Remidio smartphone fundus camera
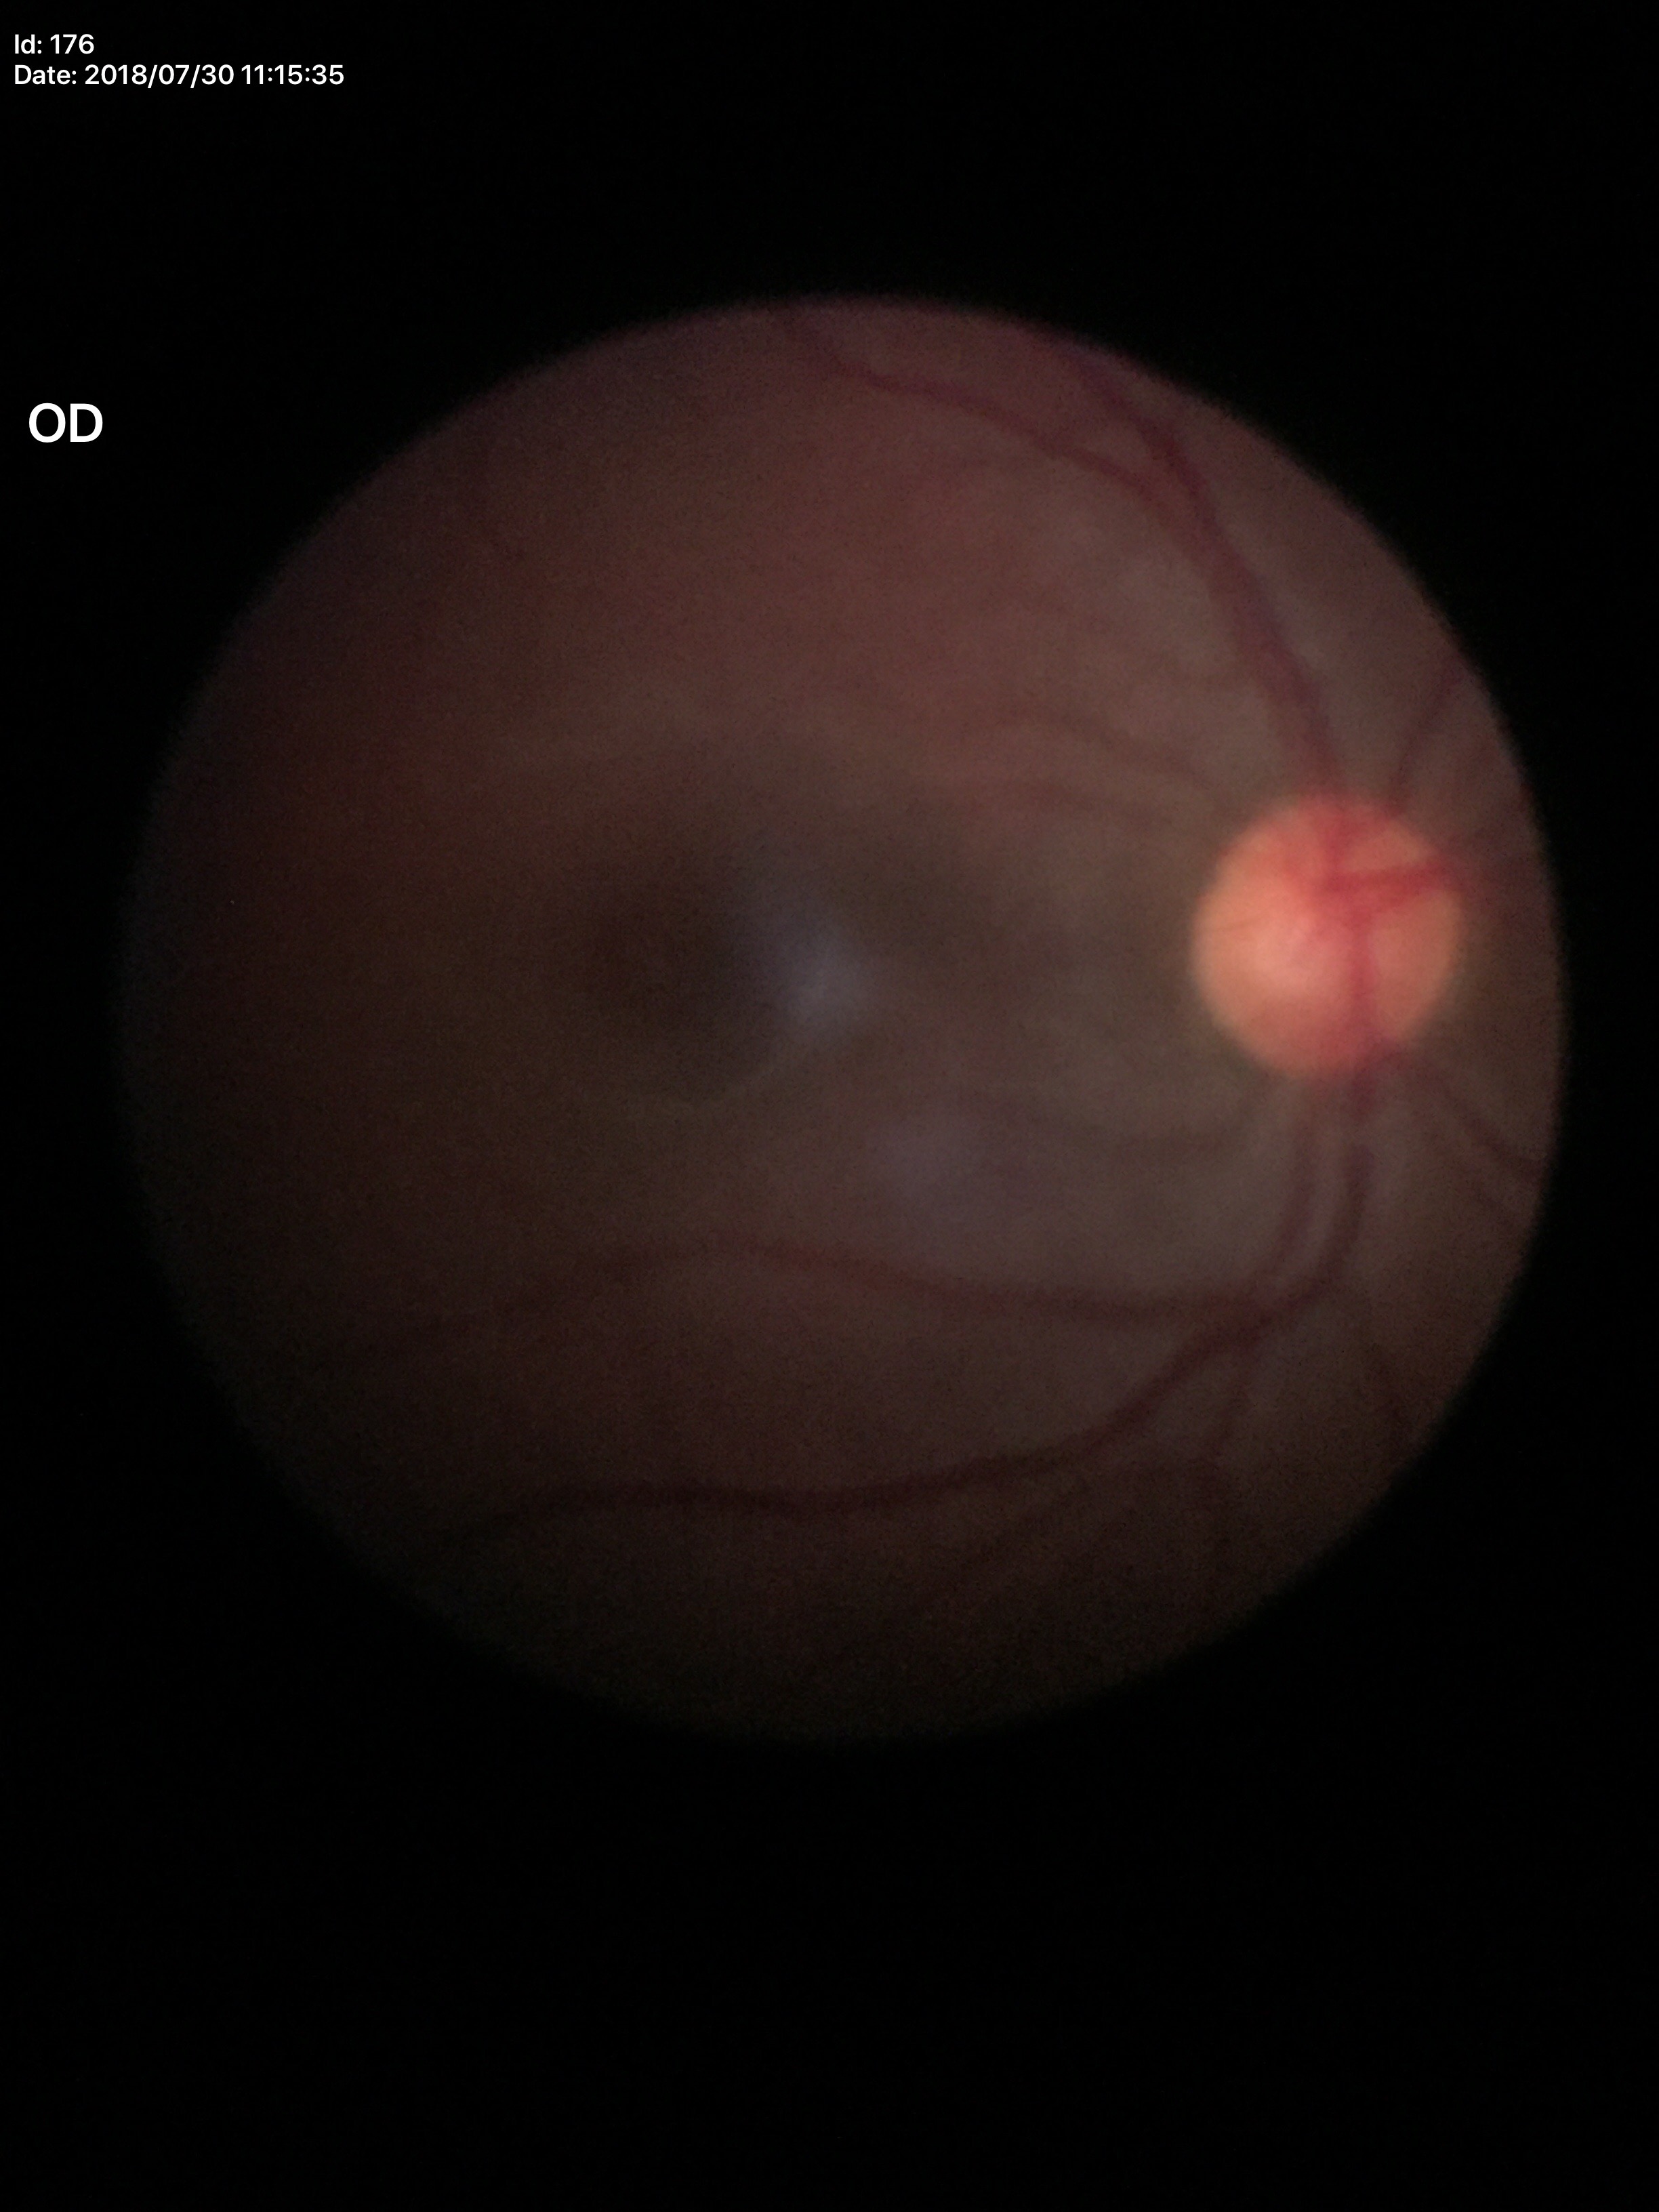 - Glaucoma screening impression: no suspicious findings
- ACDR: 0.27
- VCDR: 0.50